Remidio Fundus on Phone · 1659x2212.
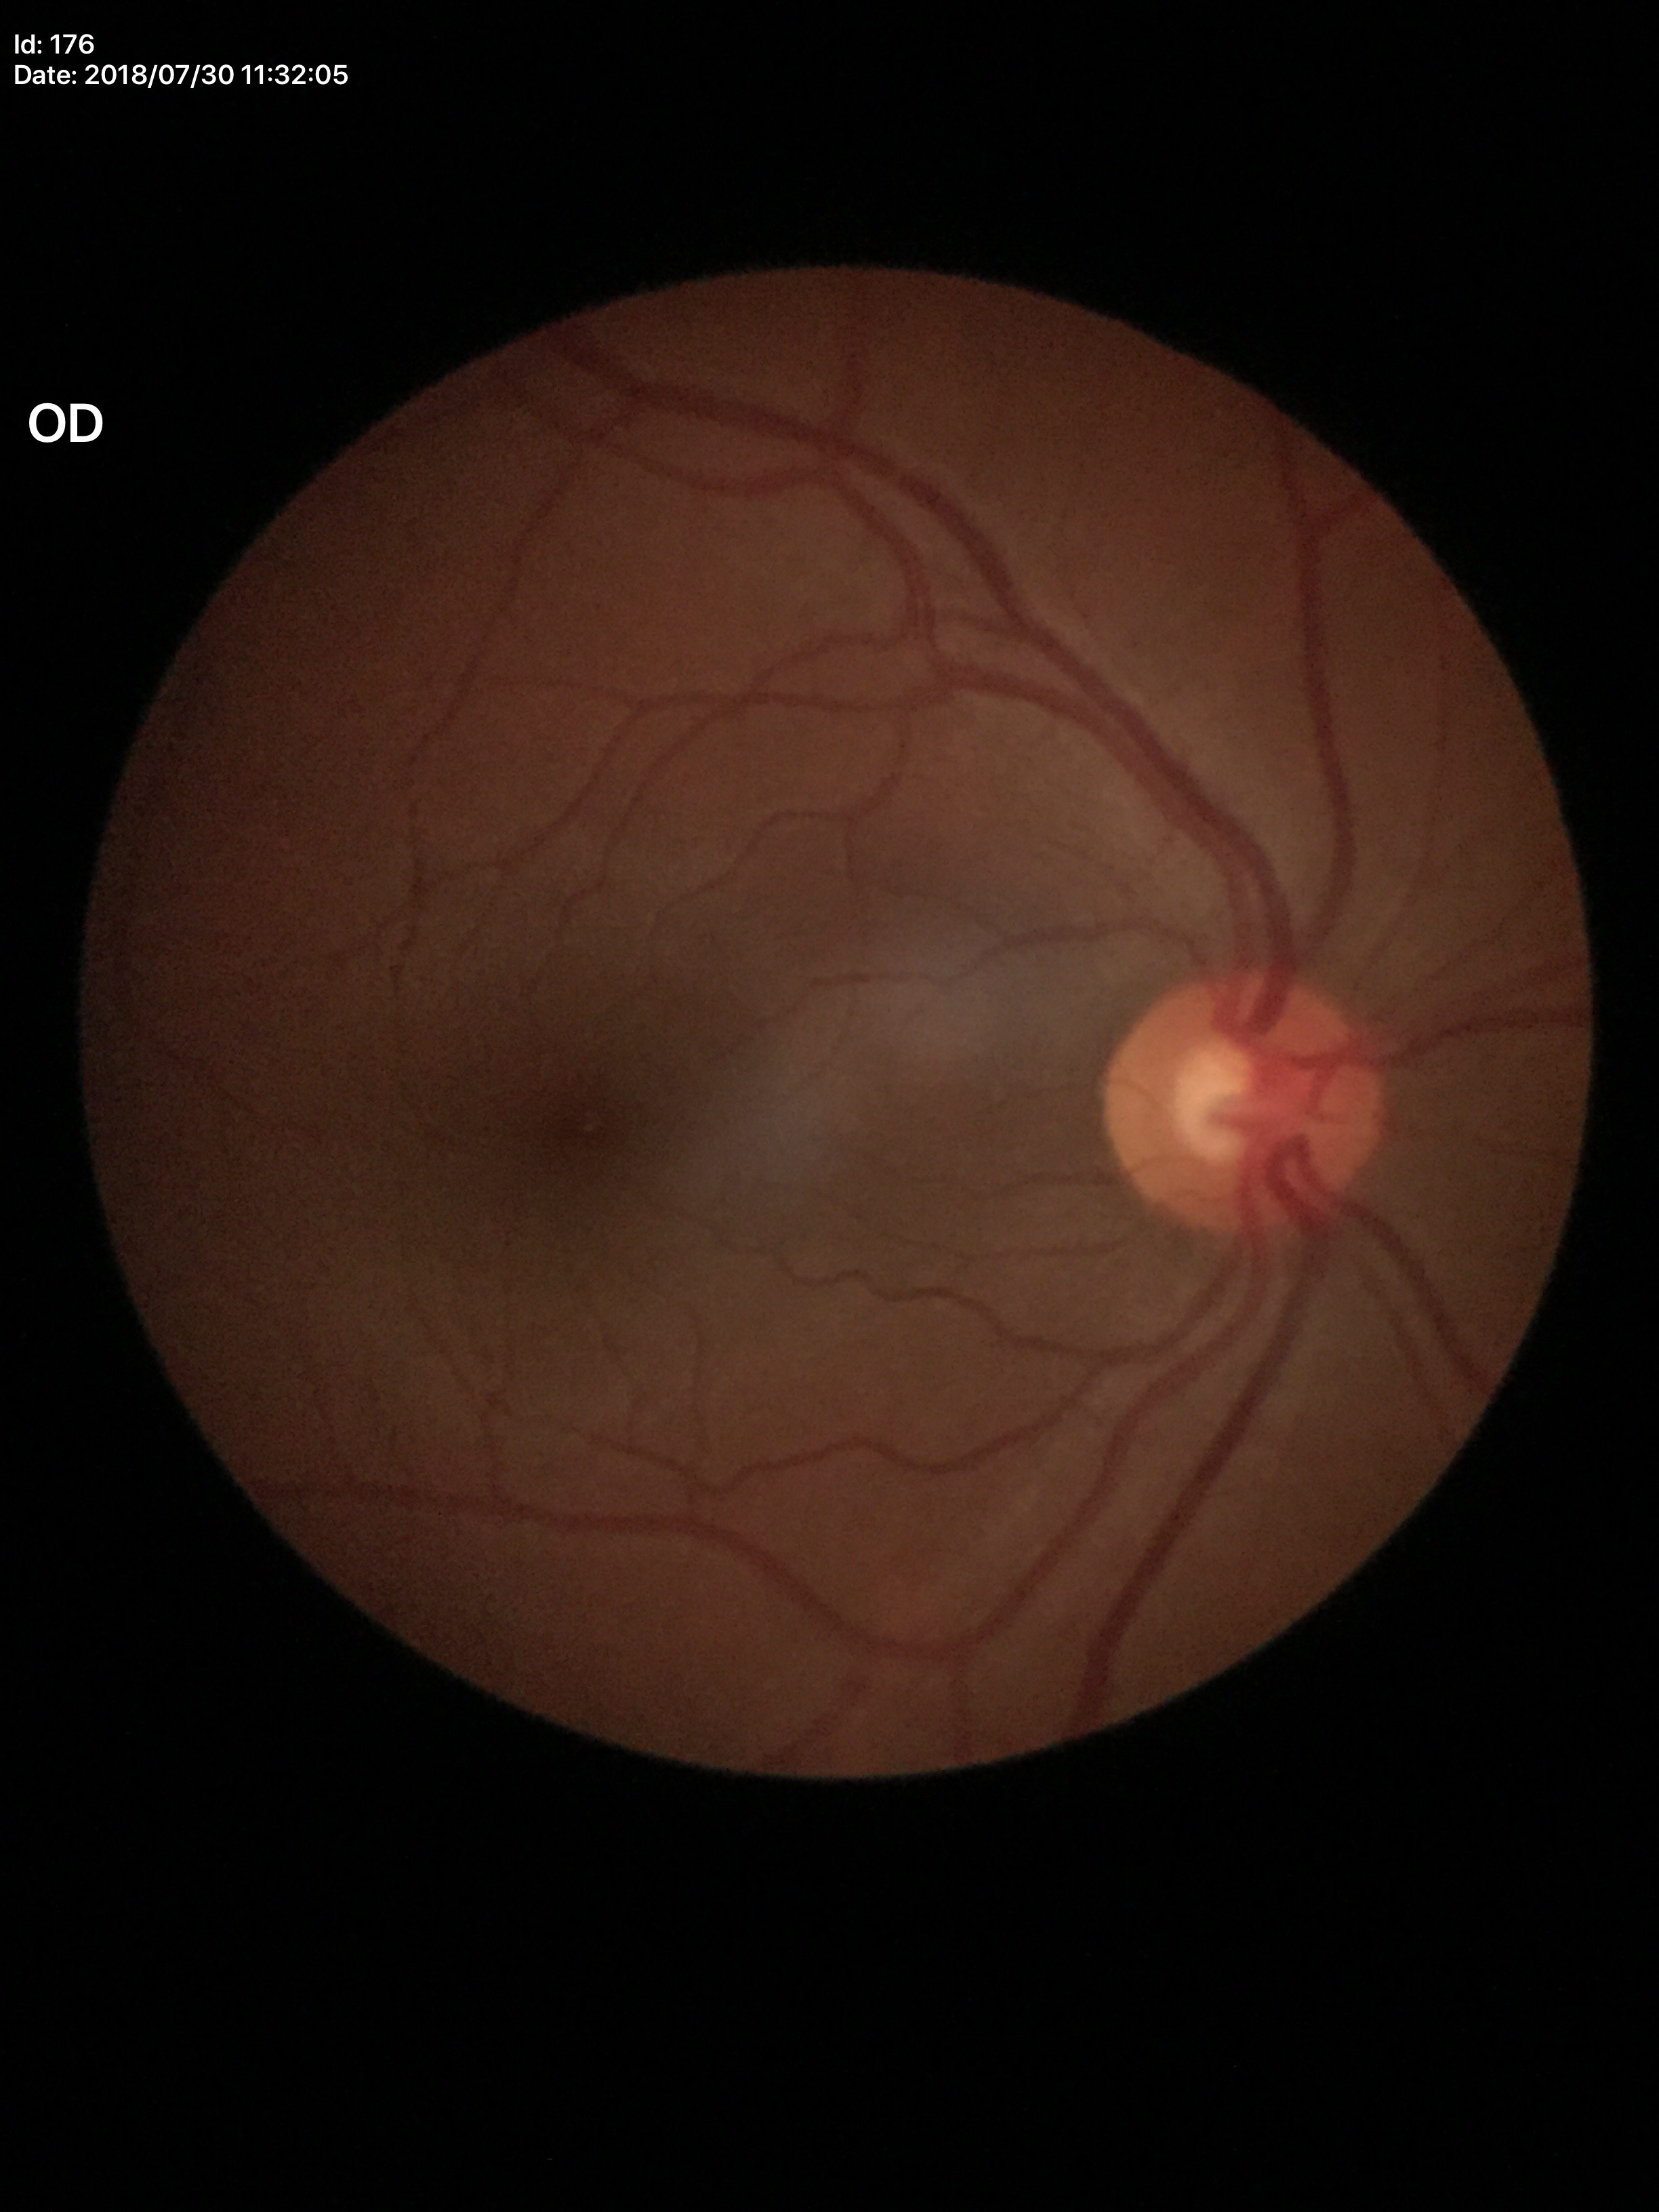
Not suspicious for glaucoma (5/5 ophthalmologists in agreement).
HCDR of 0.49.
VCDR is 0.50.